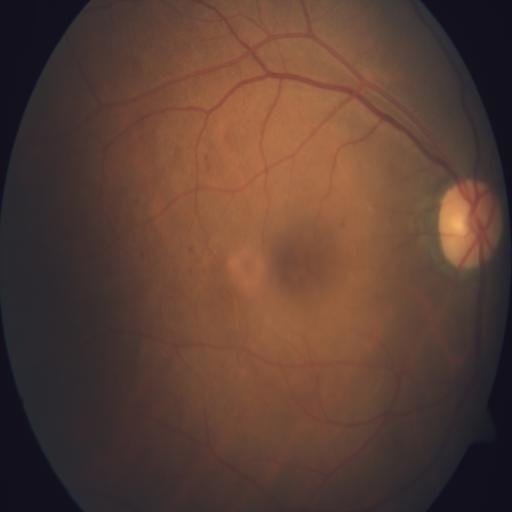

Impression: optic disc edema | media haze.